Centered on the macula:
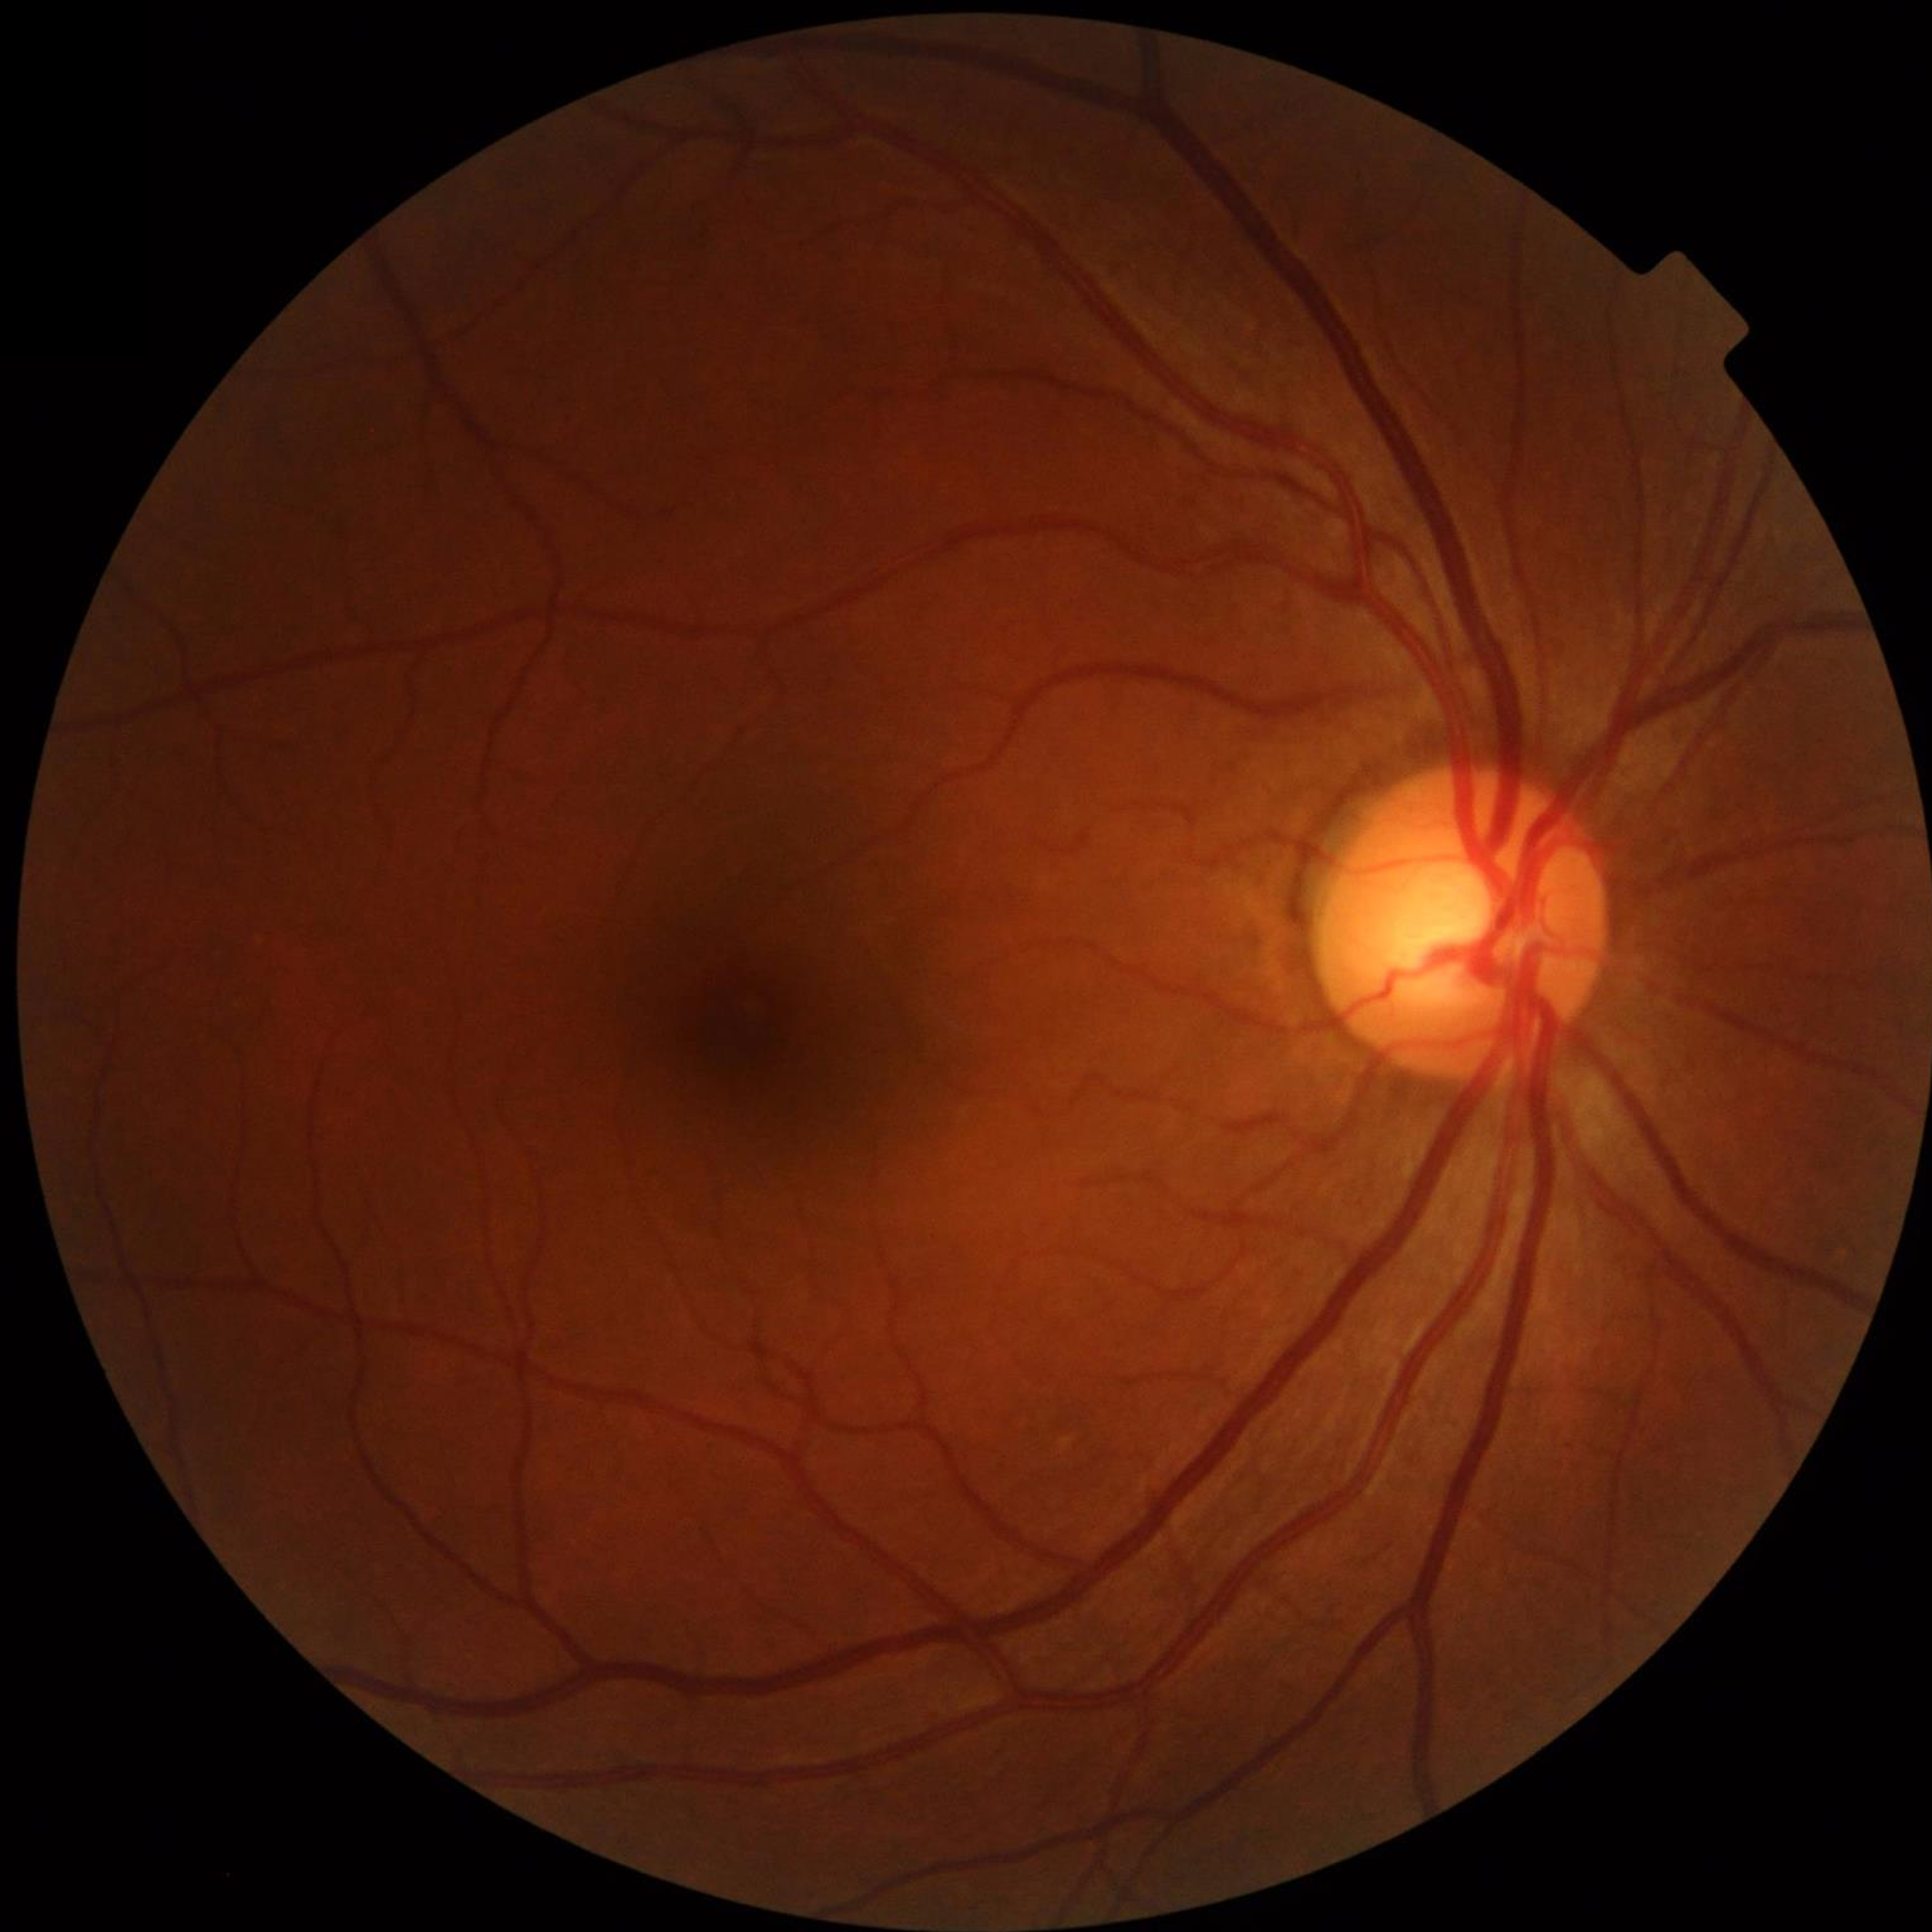
Impression: control (no AMD/DR/glaucoma)